Without pupil dilation; 45° field of view — 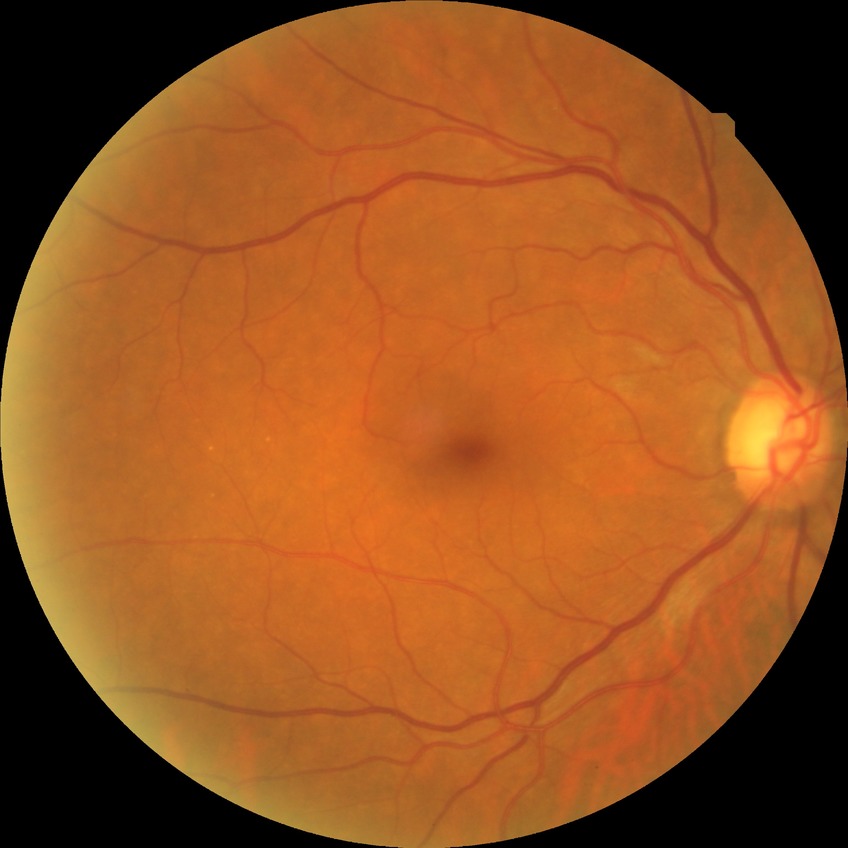
Retinopathy stage: no diabetic retinopathy.